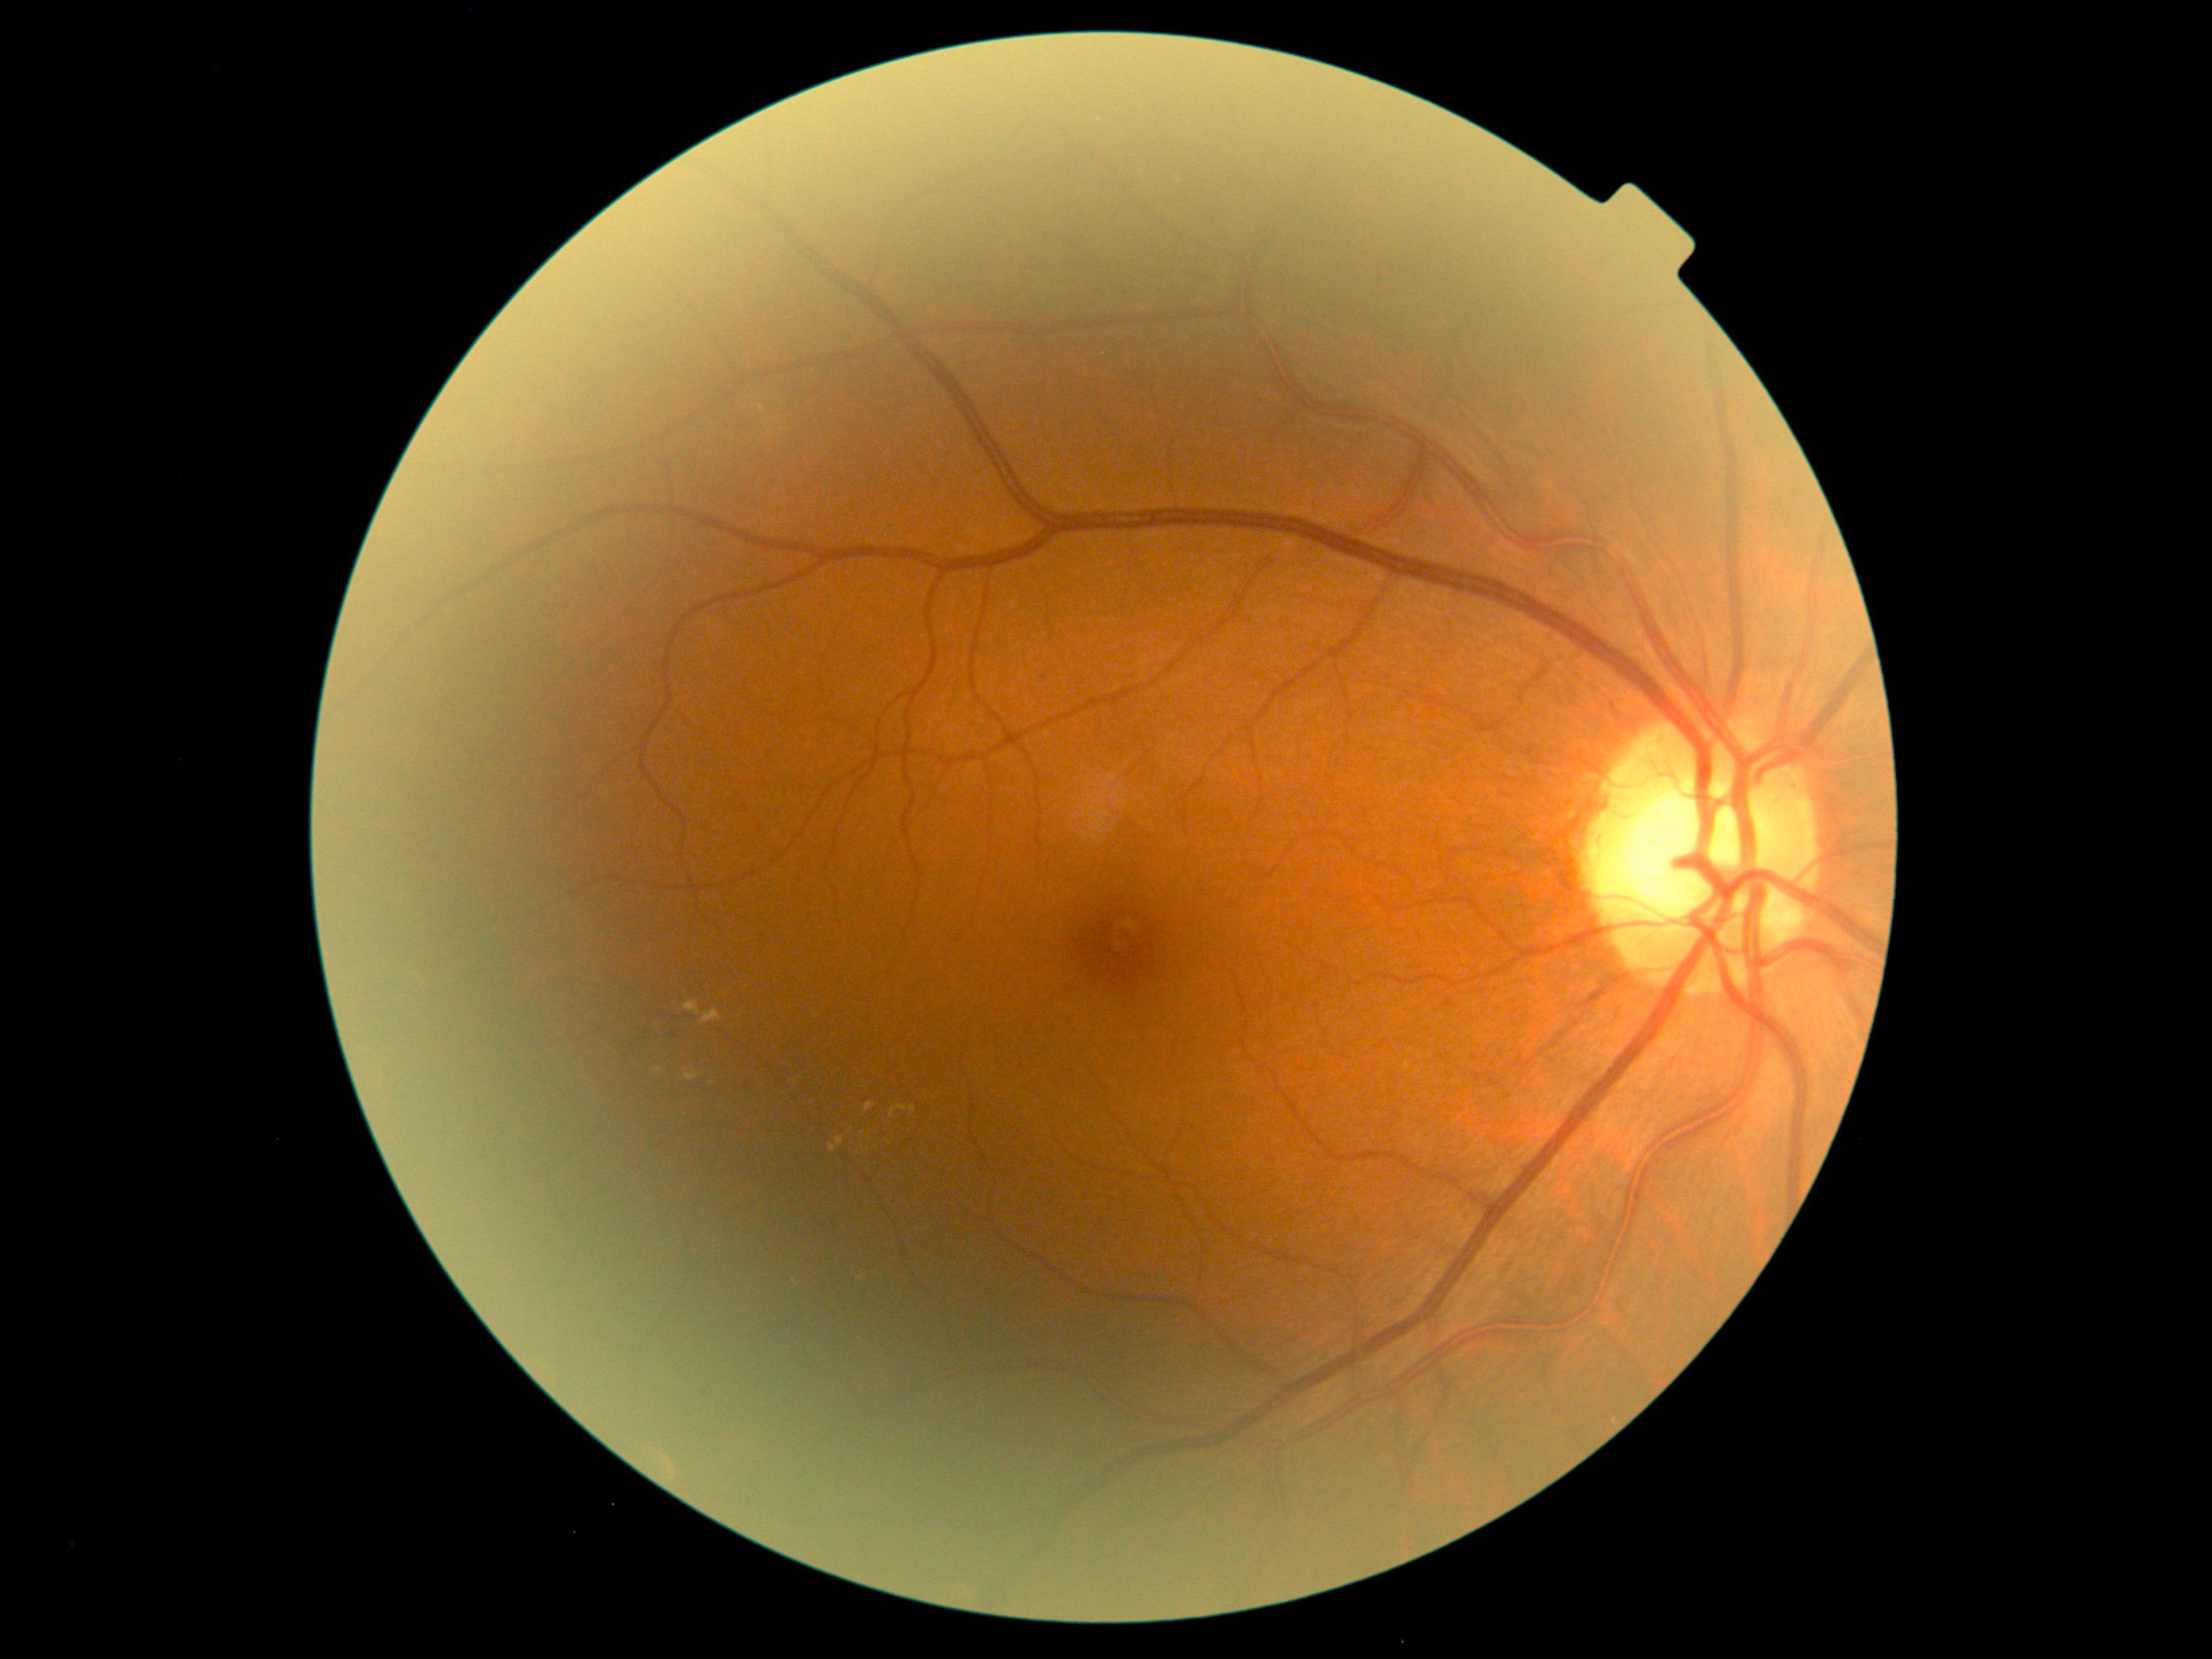
Diabetic retinopathy: grade 2 (moderate NPDR)
A subset of detected lesions:
hard exudates (more not shown): l=851, t=1272, r=861, b=1283, l=864, t=1103, r=874, b=1115, l=899, t=1105, r=916, b=1113, l=890, t=1107, r=897, b=1119, l=653, t=1019, r=661, b=1032, l=829, t=1136, r=846, b=1151, l=700, t=1009, r=722, b=1024, l=685, t=1071, r=699, b=1081, l=684, t=1001, r=701, b=1016
Small hard exudates approximately at Point(851, 1131), Point(889, 1143)
soft exudates: none identified
hemorrhages: l=619, t=1028, r=653, b=1058, l=663, t=1006, r=696, b=1042, l=1446, t=1000, r=1452, b=1008, l=1192, t=269, r=1226, b=293
microaneurysms: none identified